Modified Davis classification; 848 x 848 pixels: 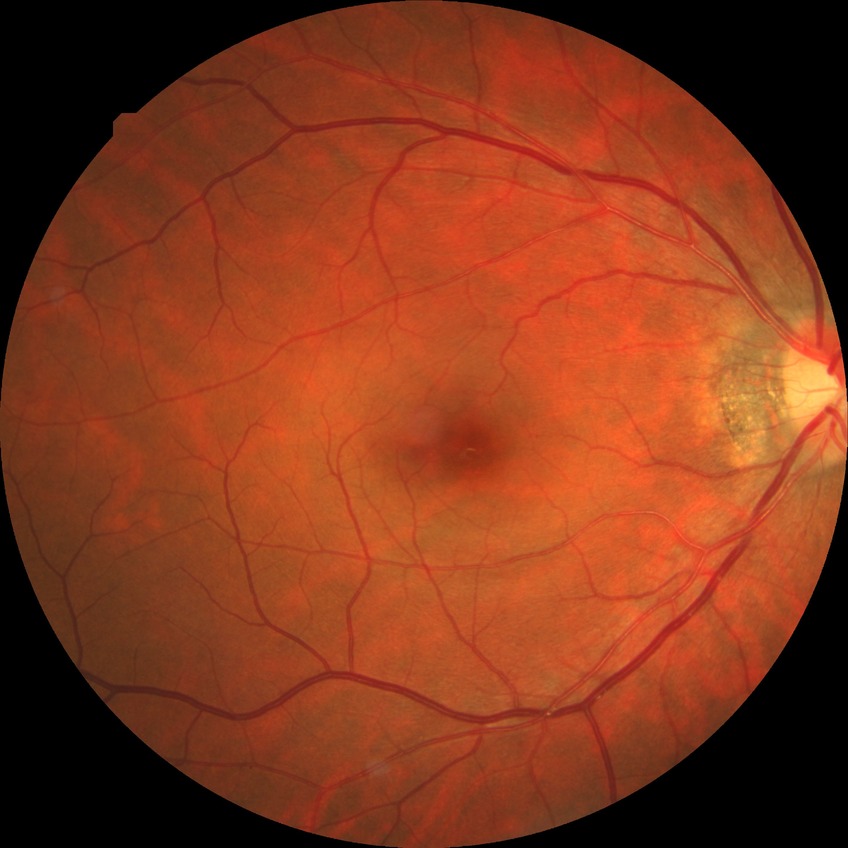

{
  "davis_grade": "no diabetic retinopathy"
}